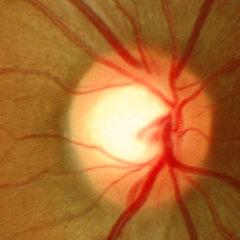 Showing early glaucomatous changes.